Color fundus image; 2352x1568; FOV: 45 degrees — 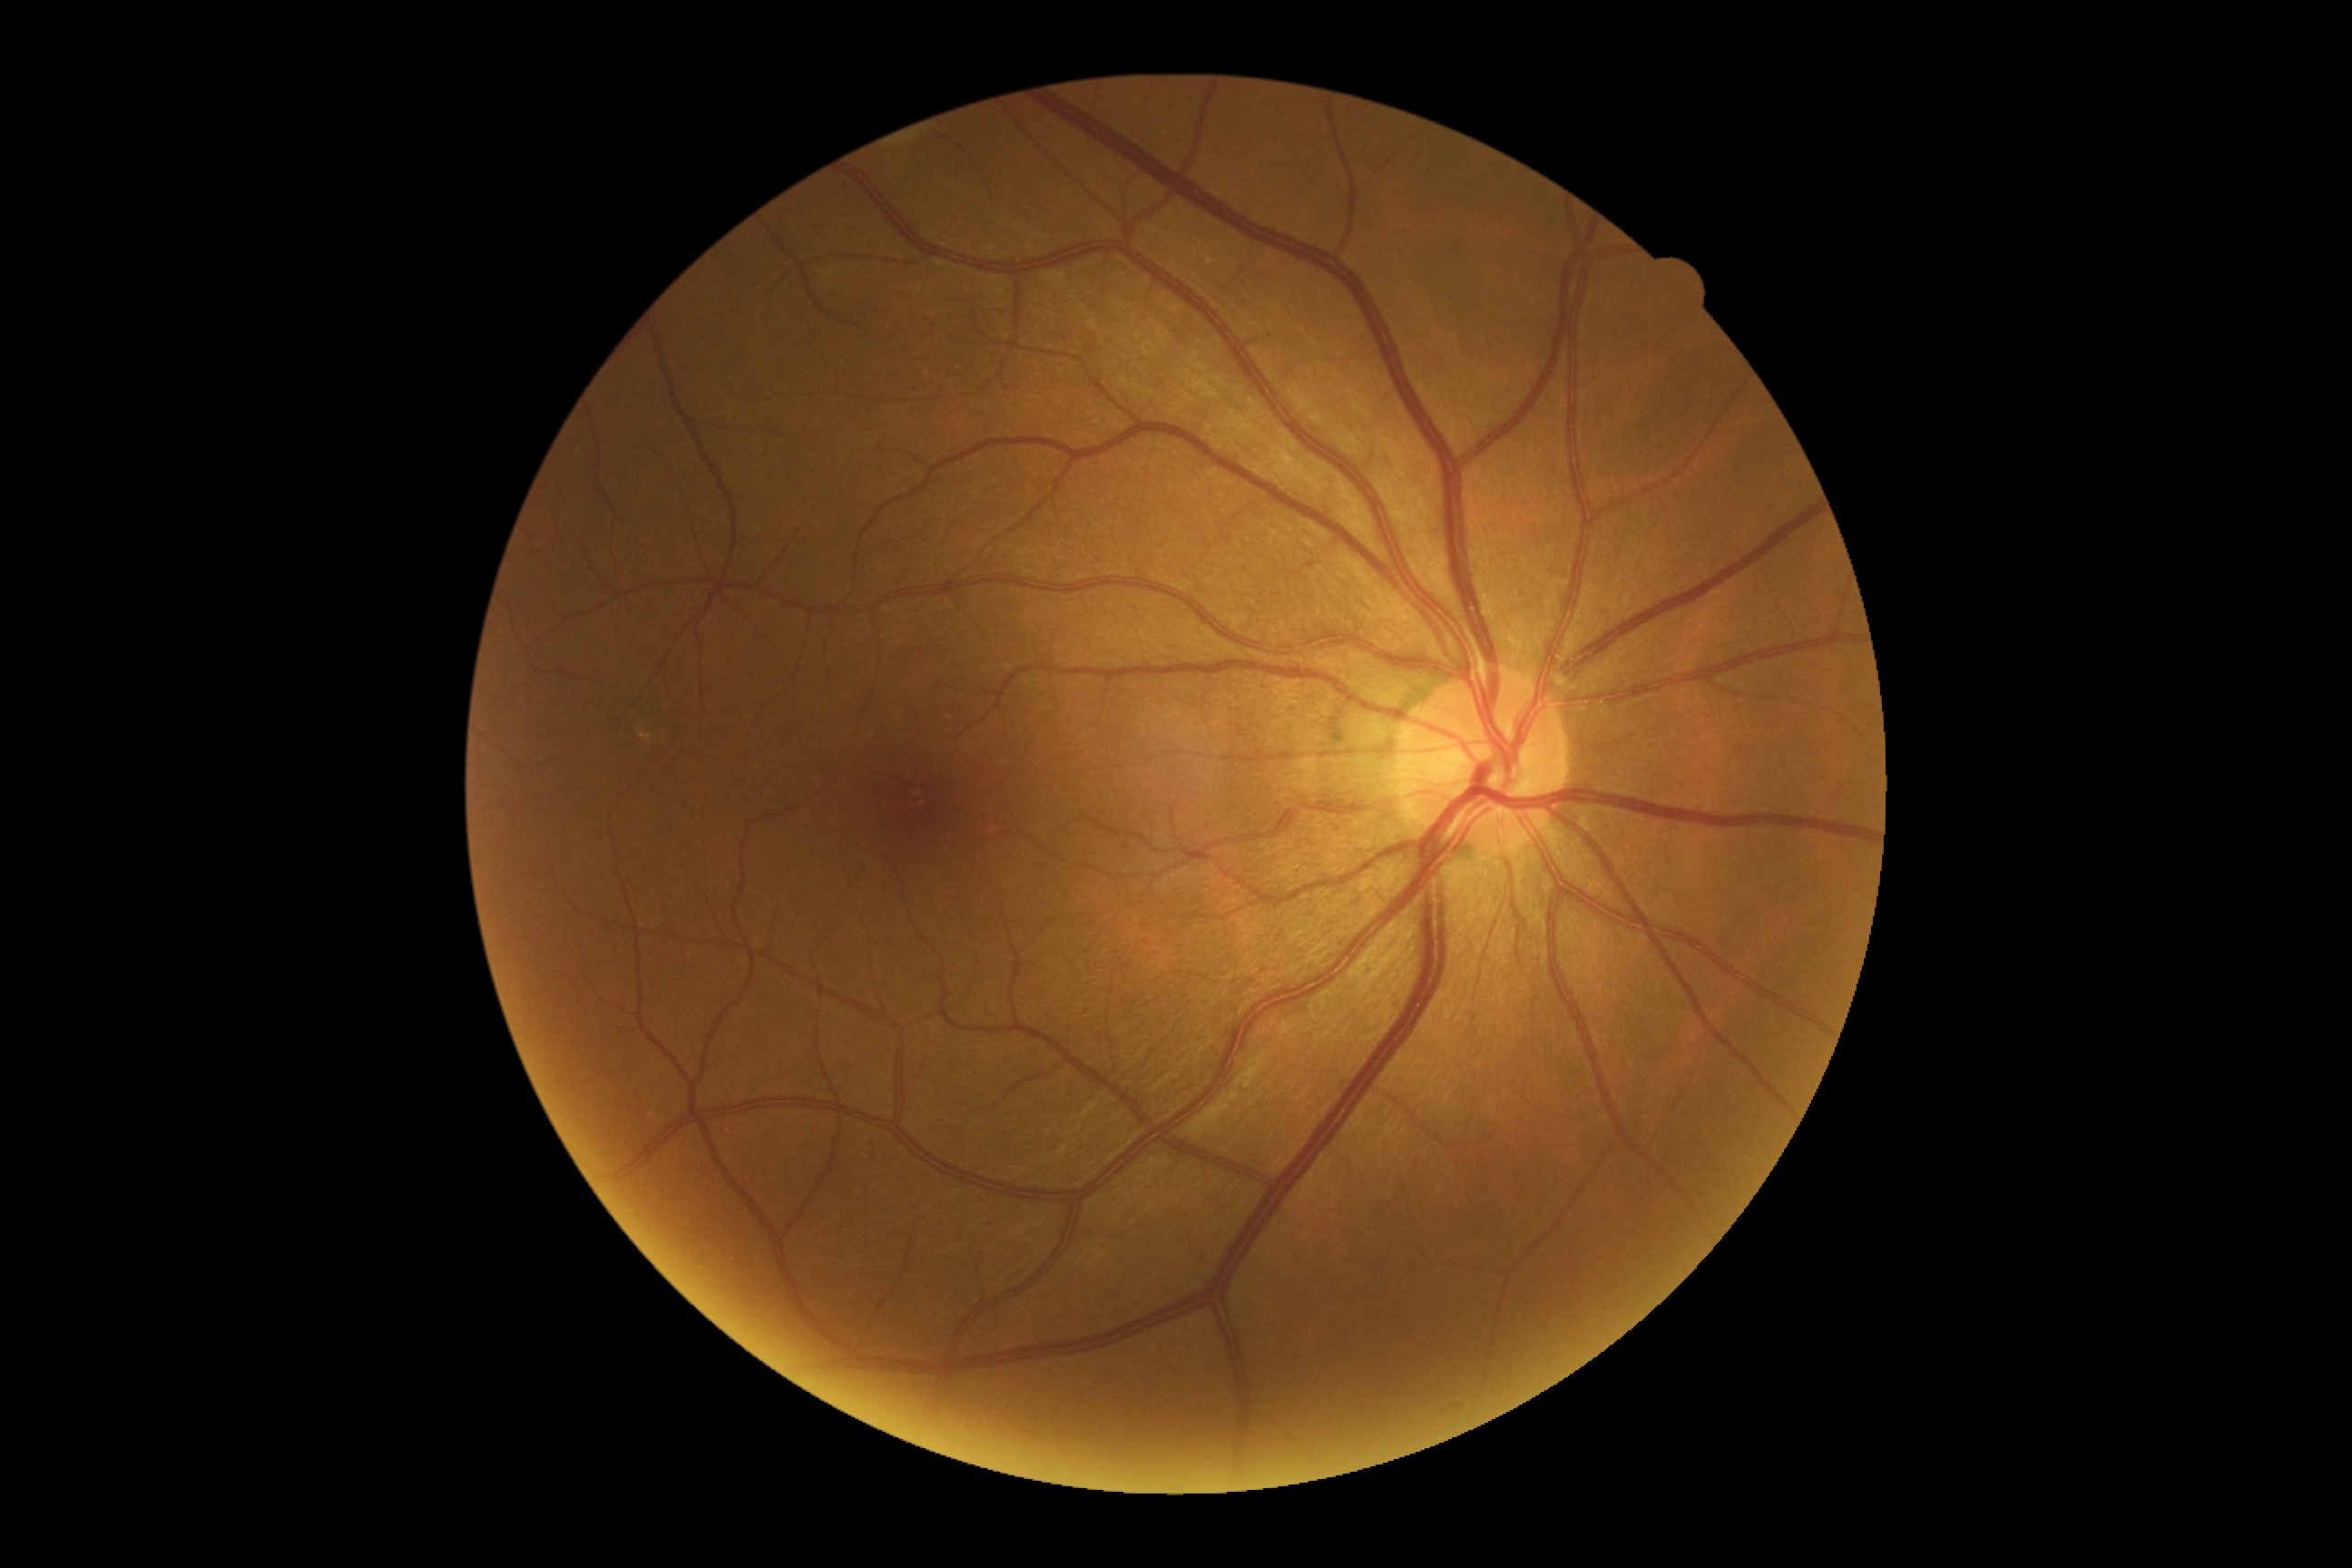 Retinopathy grade: no apparent diabetic retinopathy (0).